NIDEK AFC-230 fundus camera
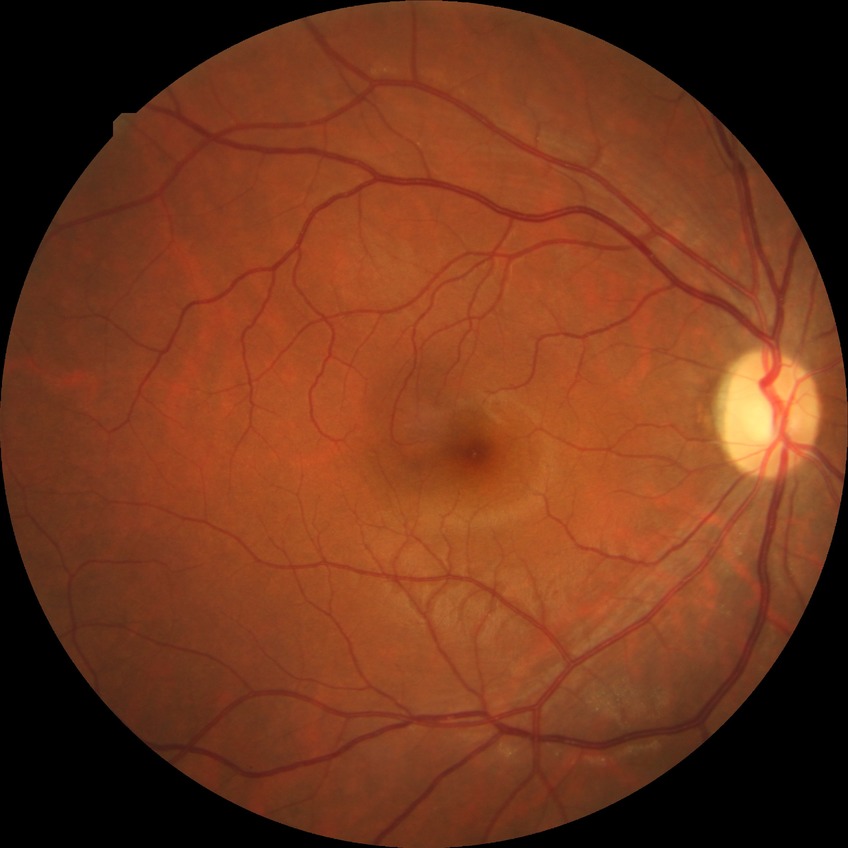
diabetic retinopathy (DR): NDR (no diabetic retinopathy)